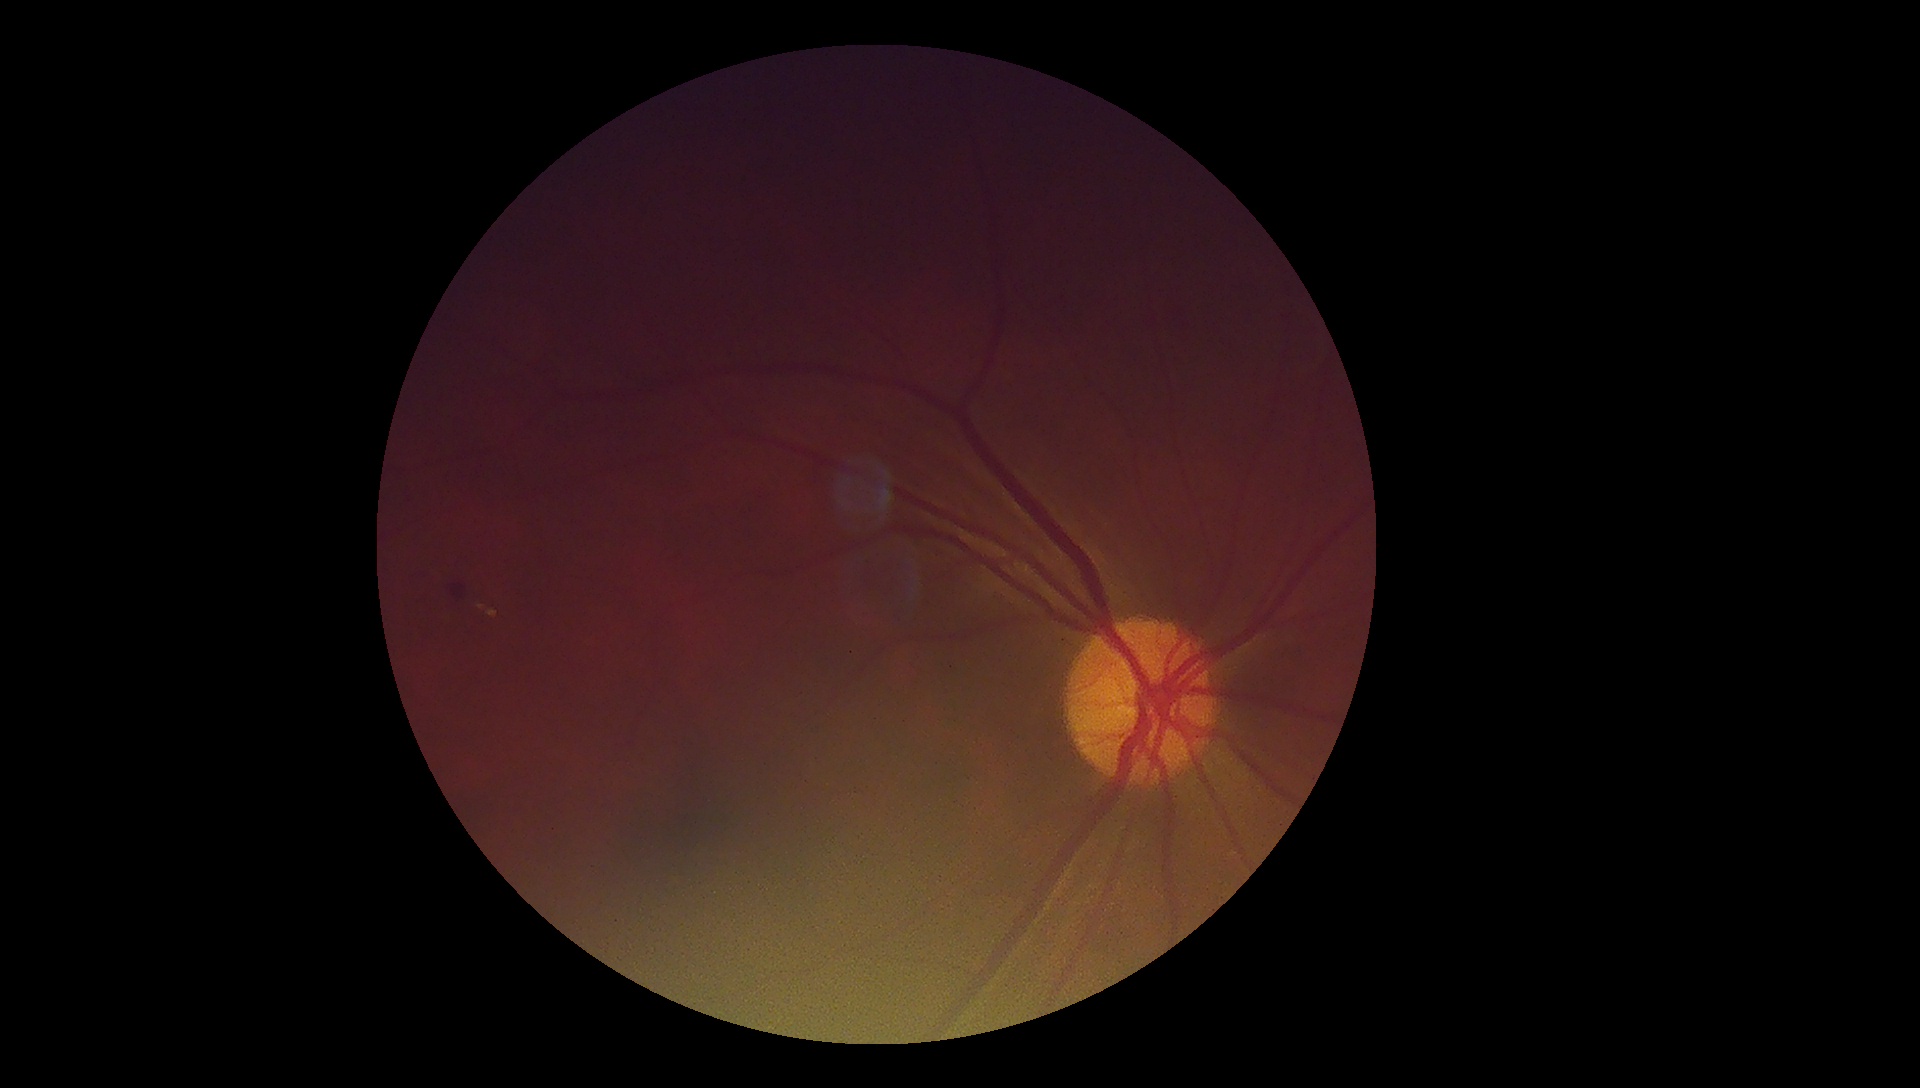
Diabetic retinopathy (DR) is grade 2 (moderate NPDR) — more than just microaneurysms but less than severe NPDR.